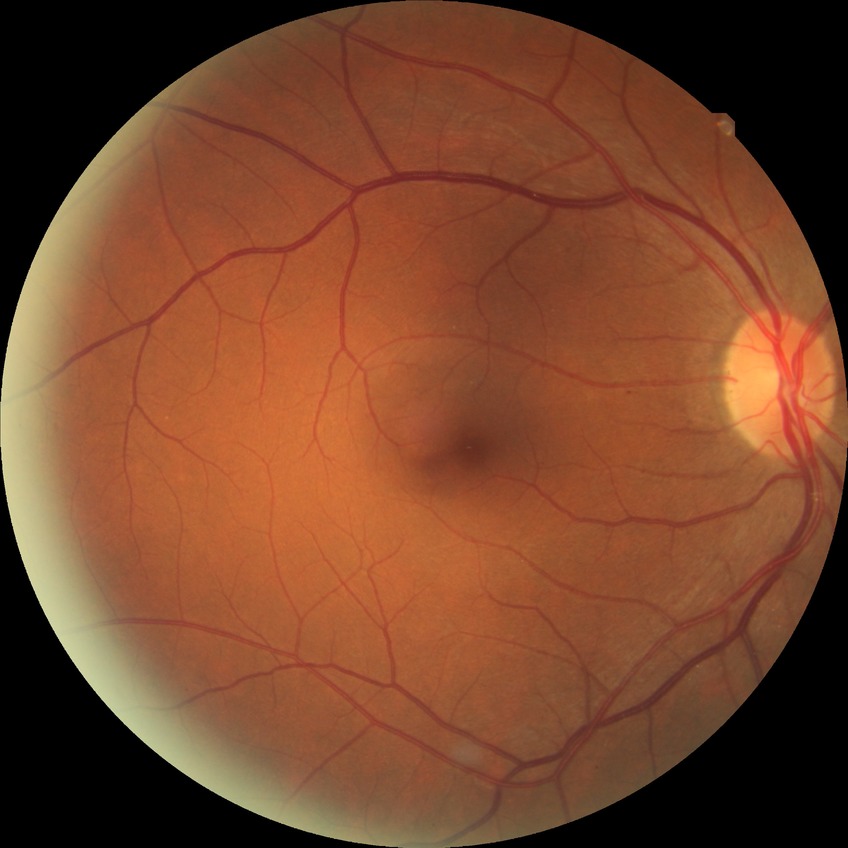

Retinopathy stage is no diabetic retinopathy.